45-degree field of view. Color fundus image.
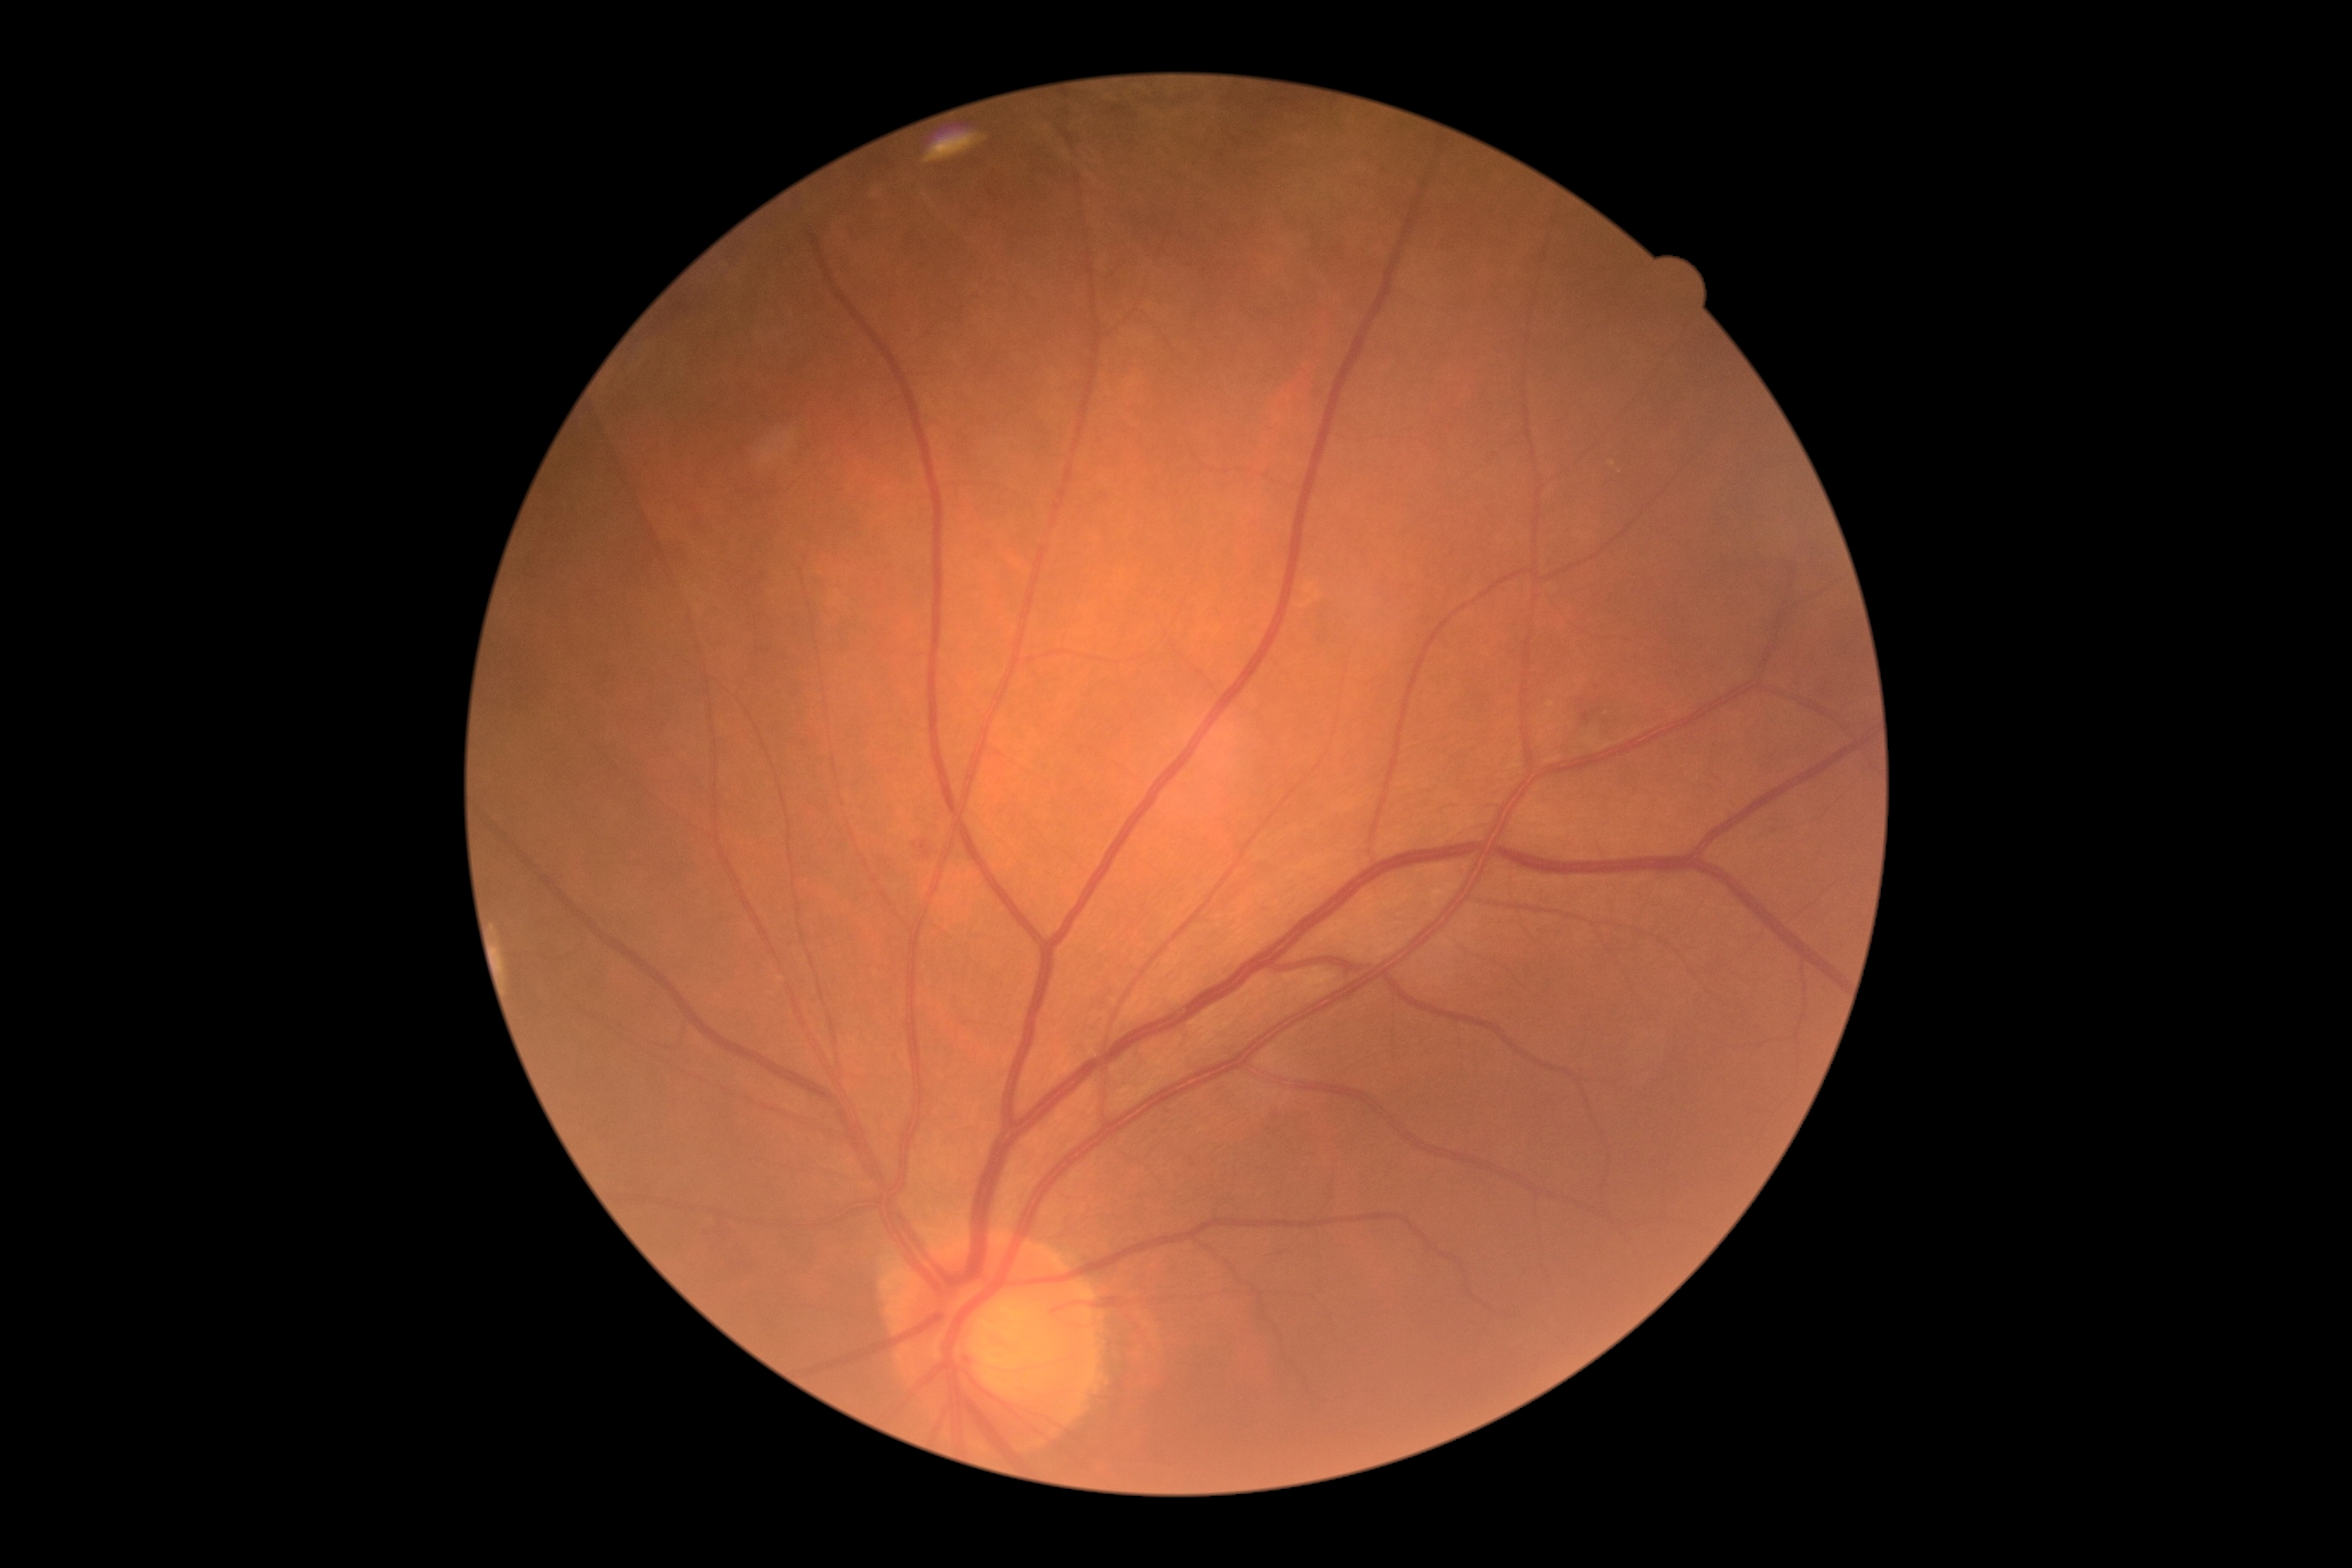

Retinopathy grade: 2 (moderate NPDR). DR class: non-proliferative diabetic retinopathy.